Davis DR grading
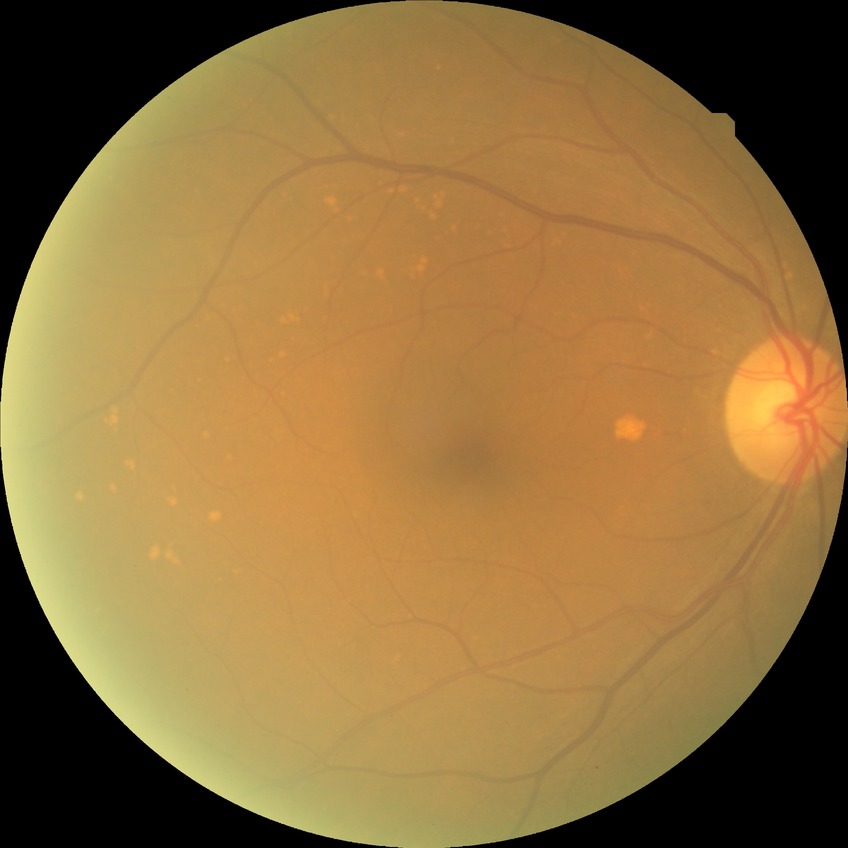

Annotations:
• modified Davis classification — no diabetic retinopathy